Retinal fundus photograph; 45° field of view
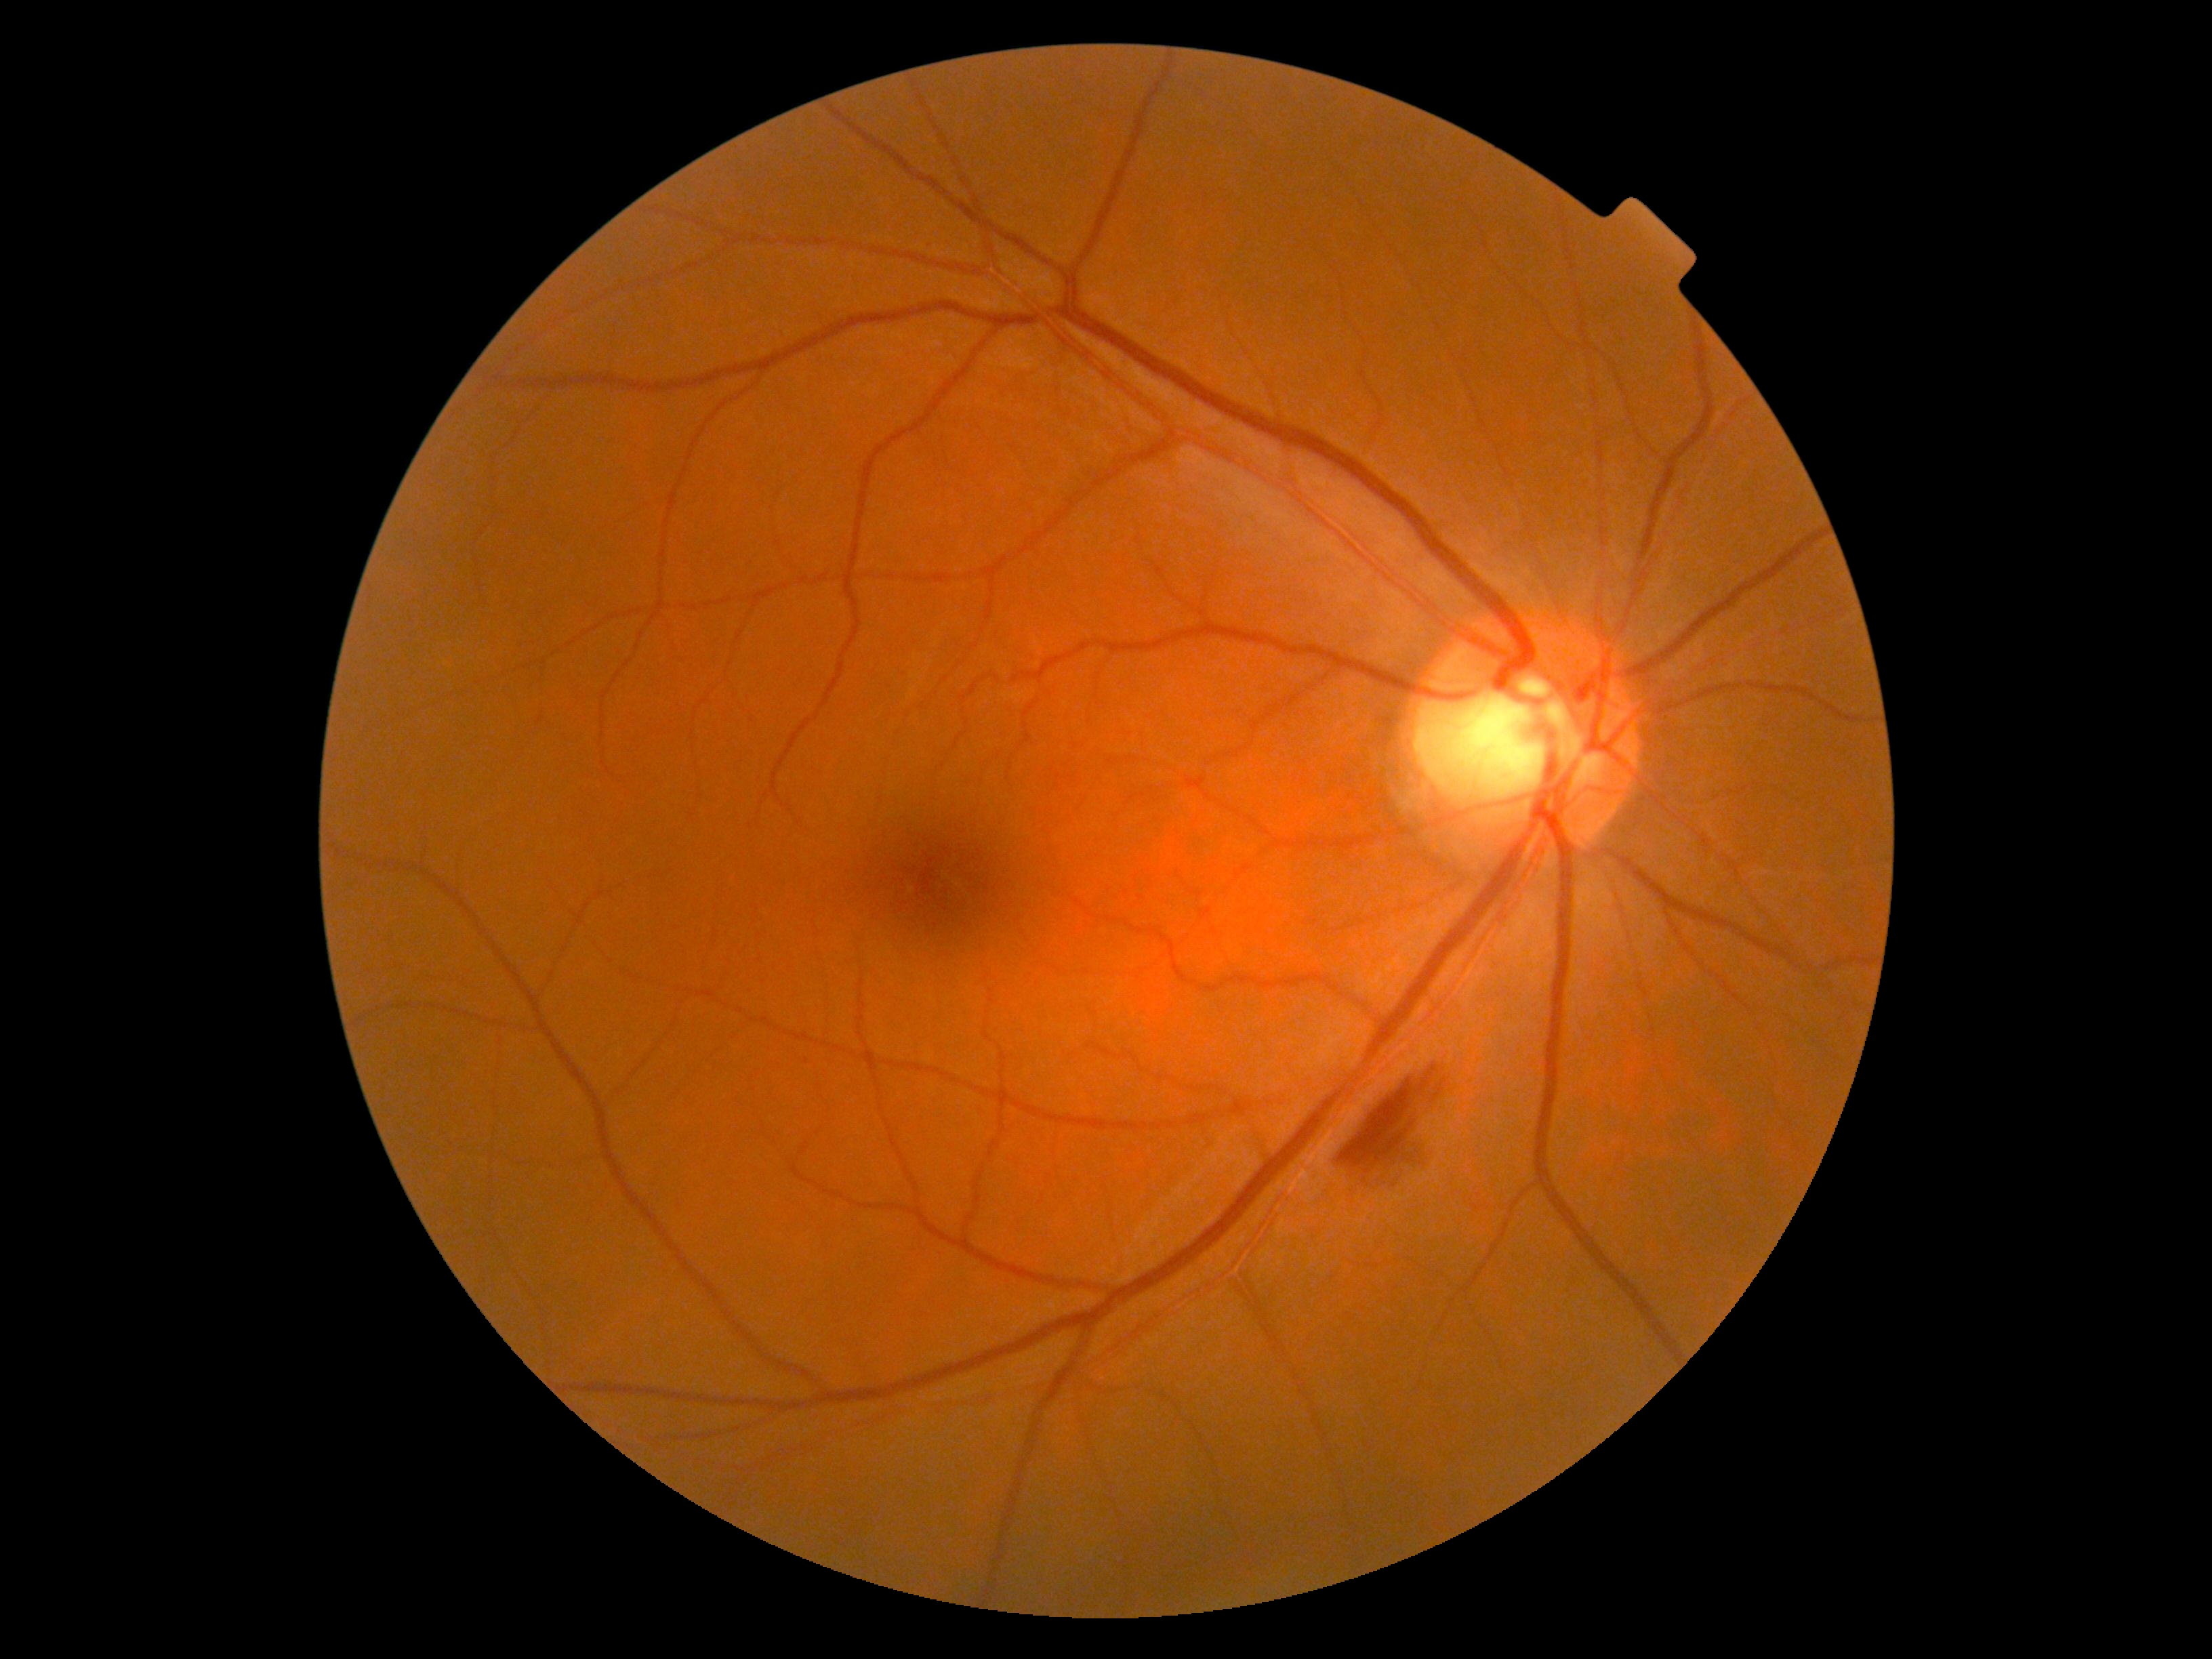
DR severity: moderate NPDR (grade 2) — more than just microaneurysms but less than severe NPDR.